2352 by 1568 pixels. FOV: 45 degrees. Retinal fundus photograph — 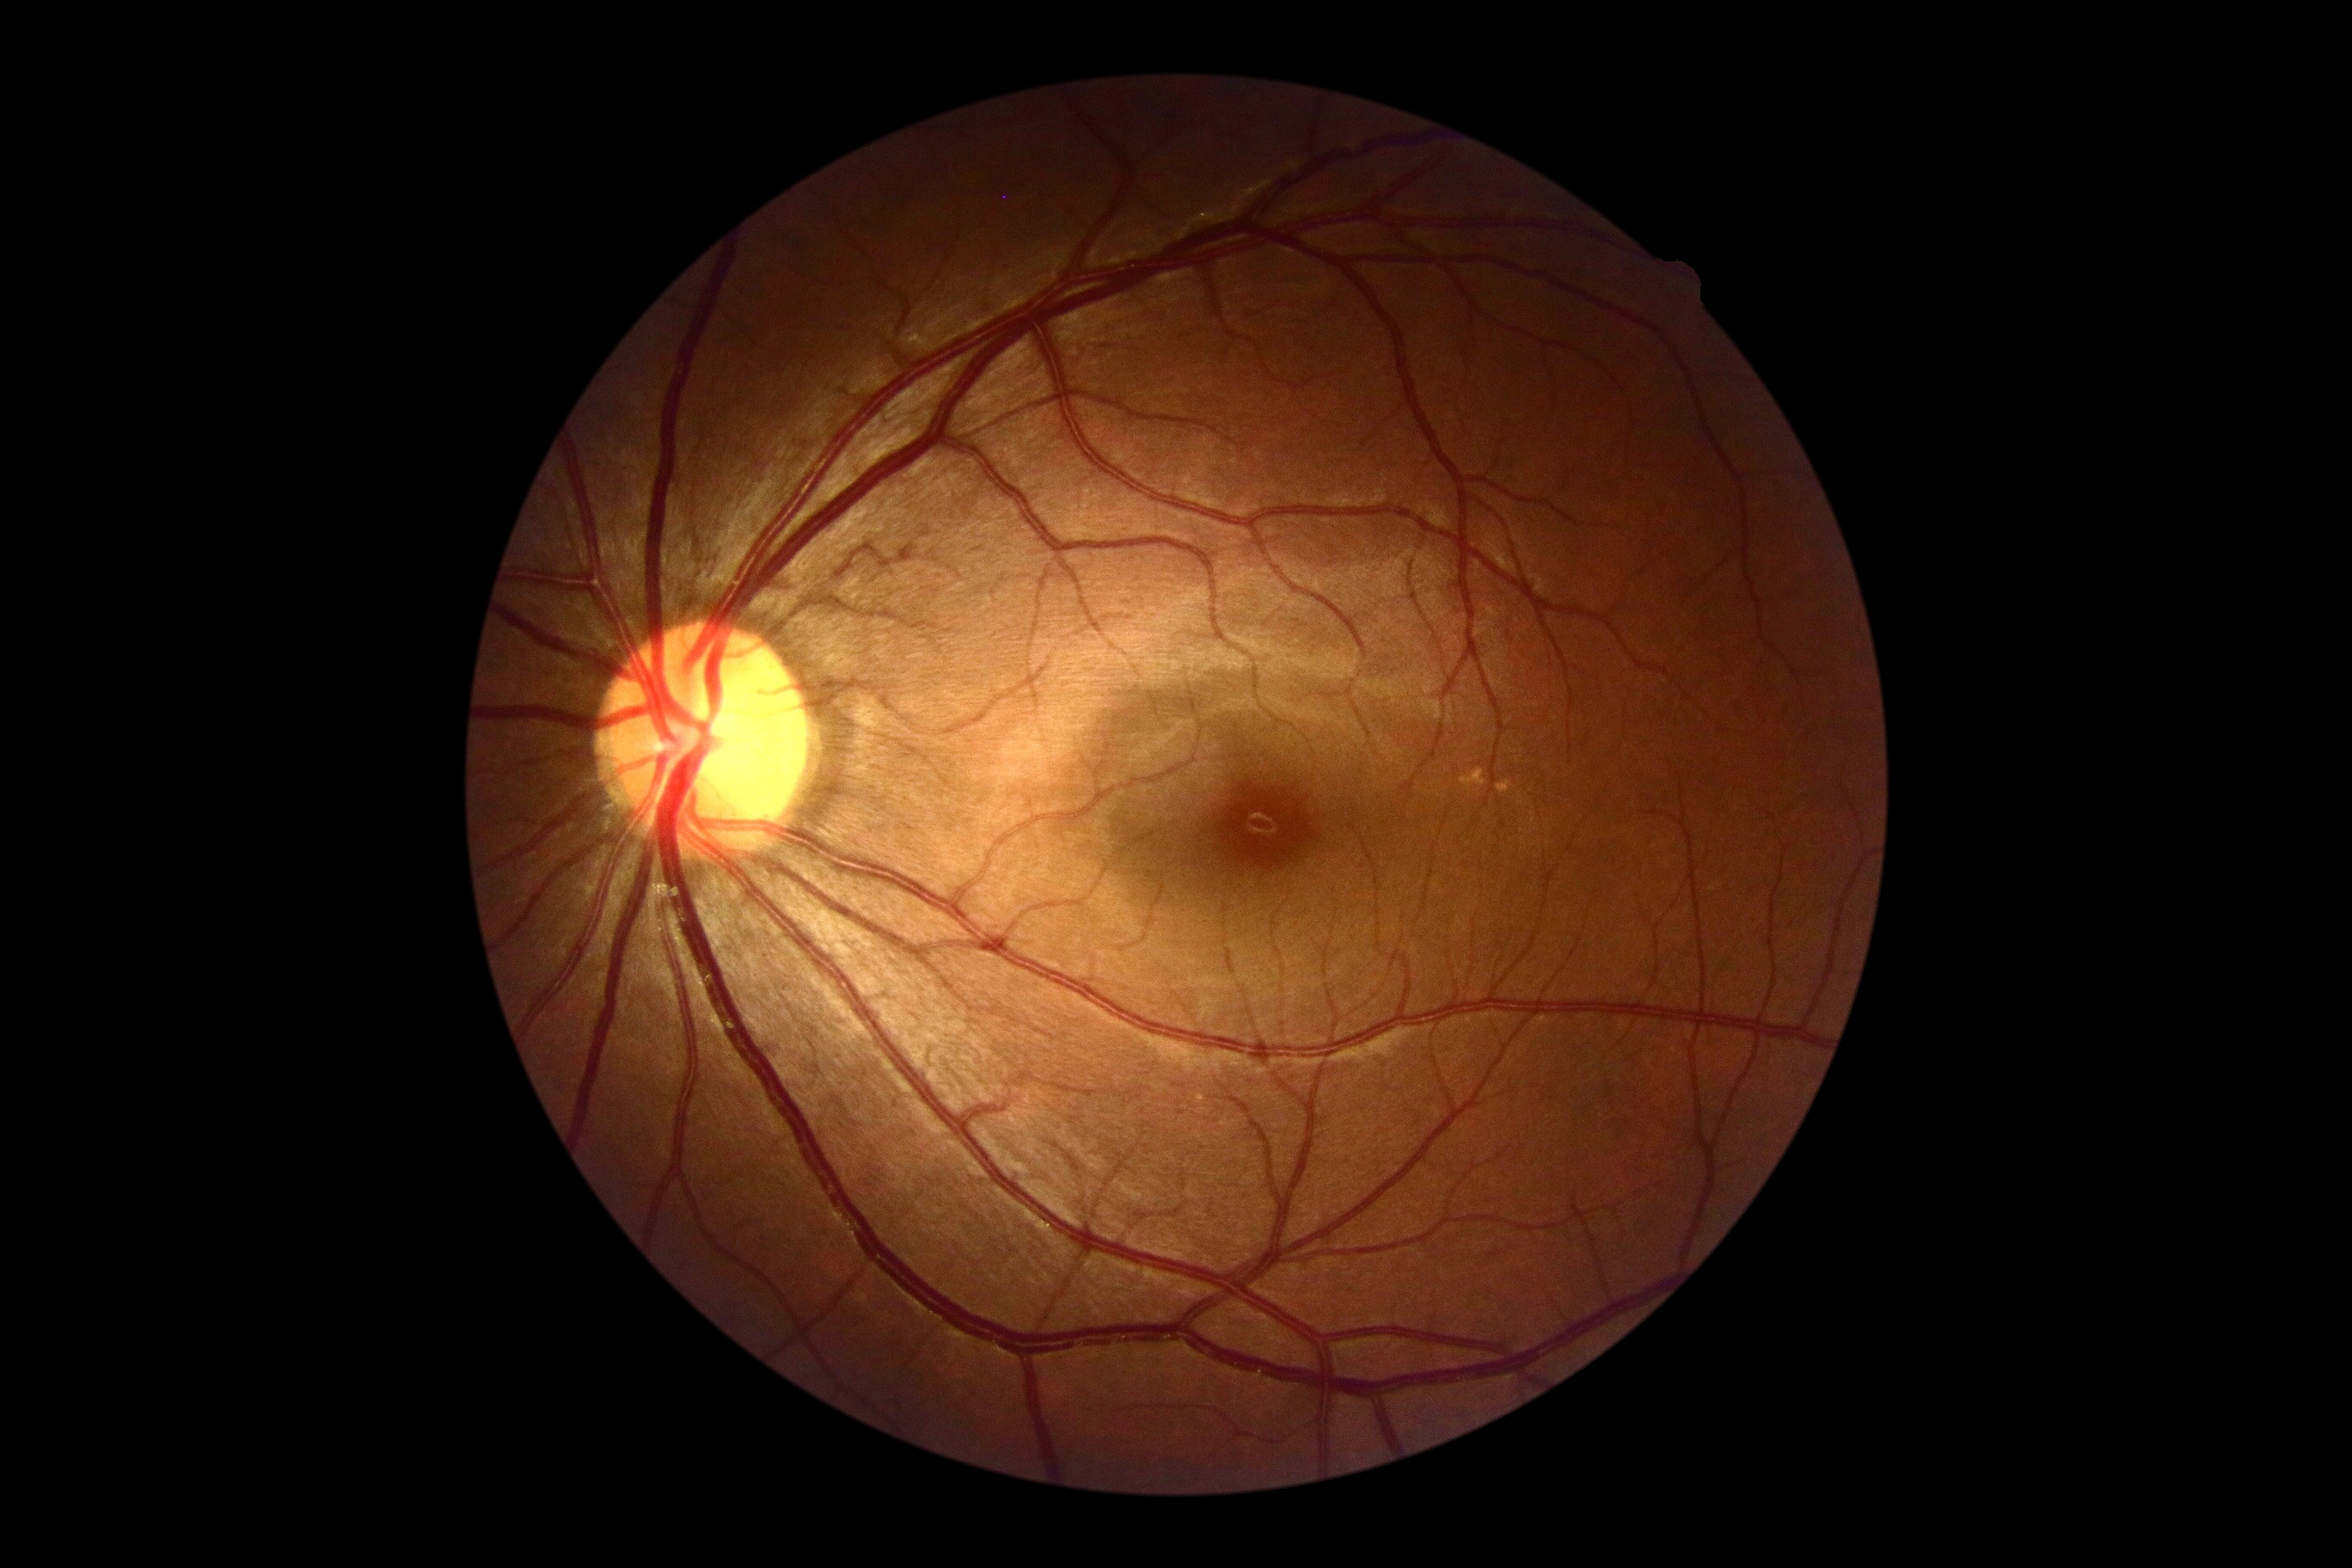

Retinopathy is 0 — no visible signs of diabetic retinopathy.